Phoenix ICON wide-field infant fundus image:
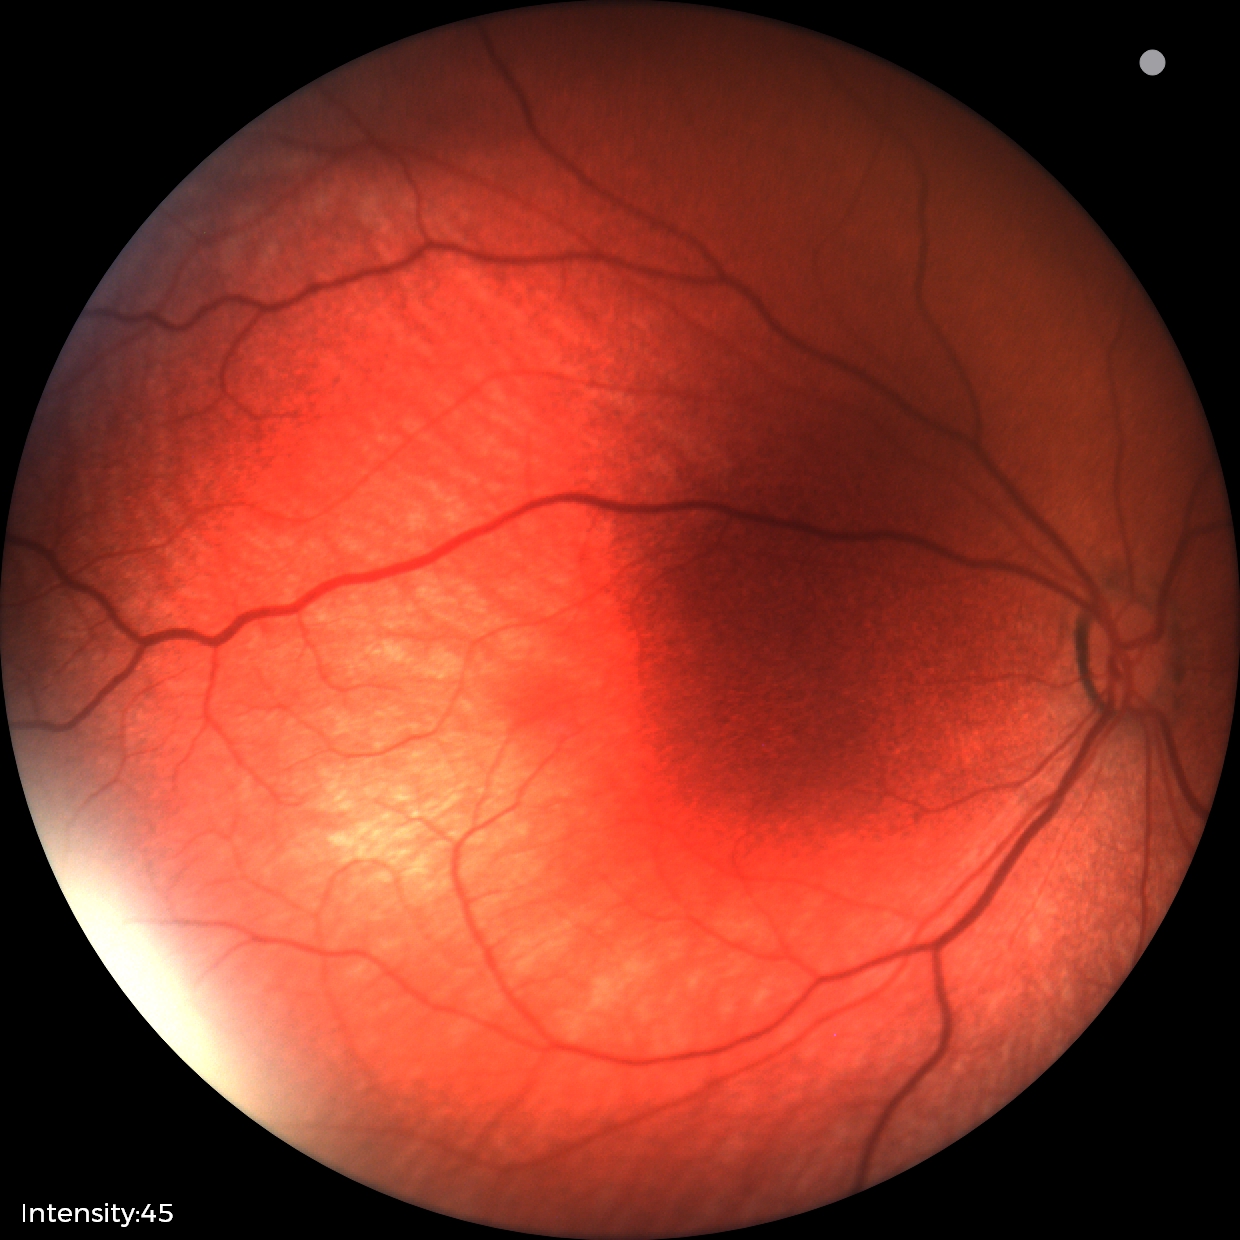

Q: What is the screening diagnosis?
A: normal fundus examination